2352 x 1568 pixels:
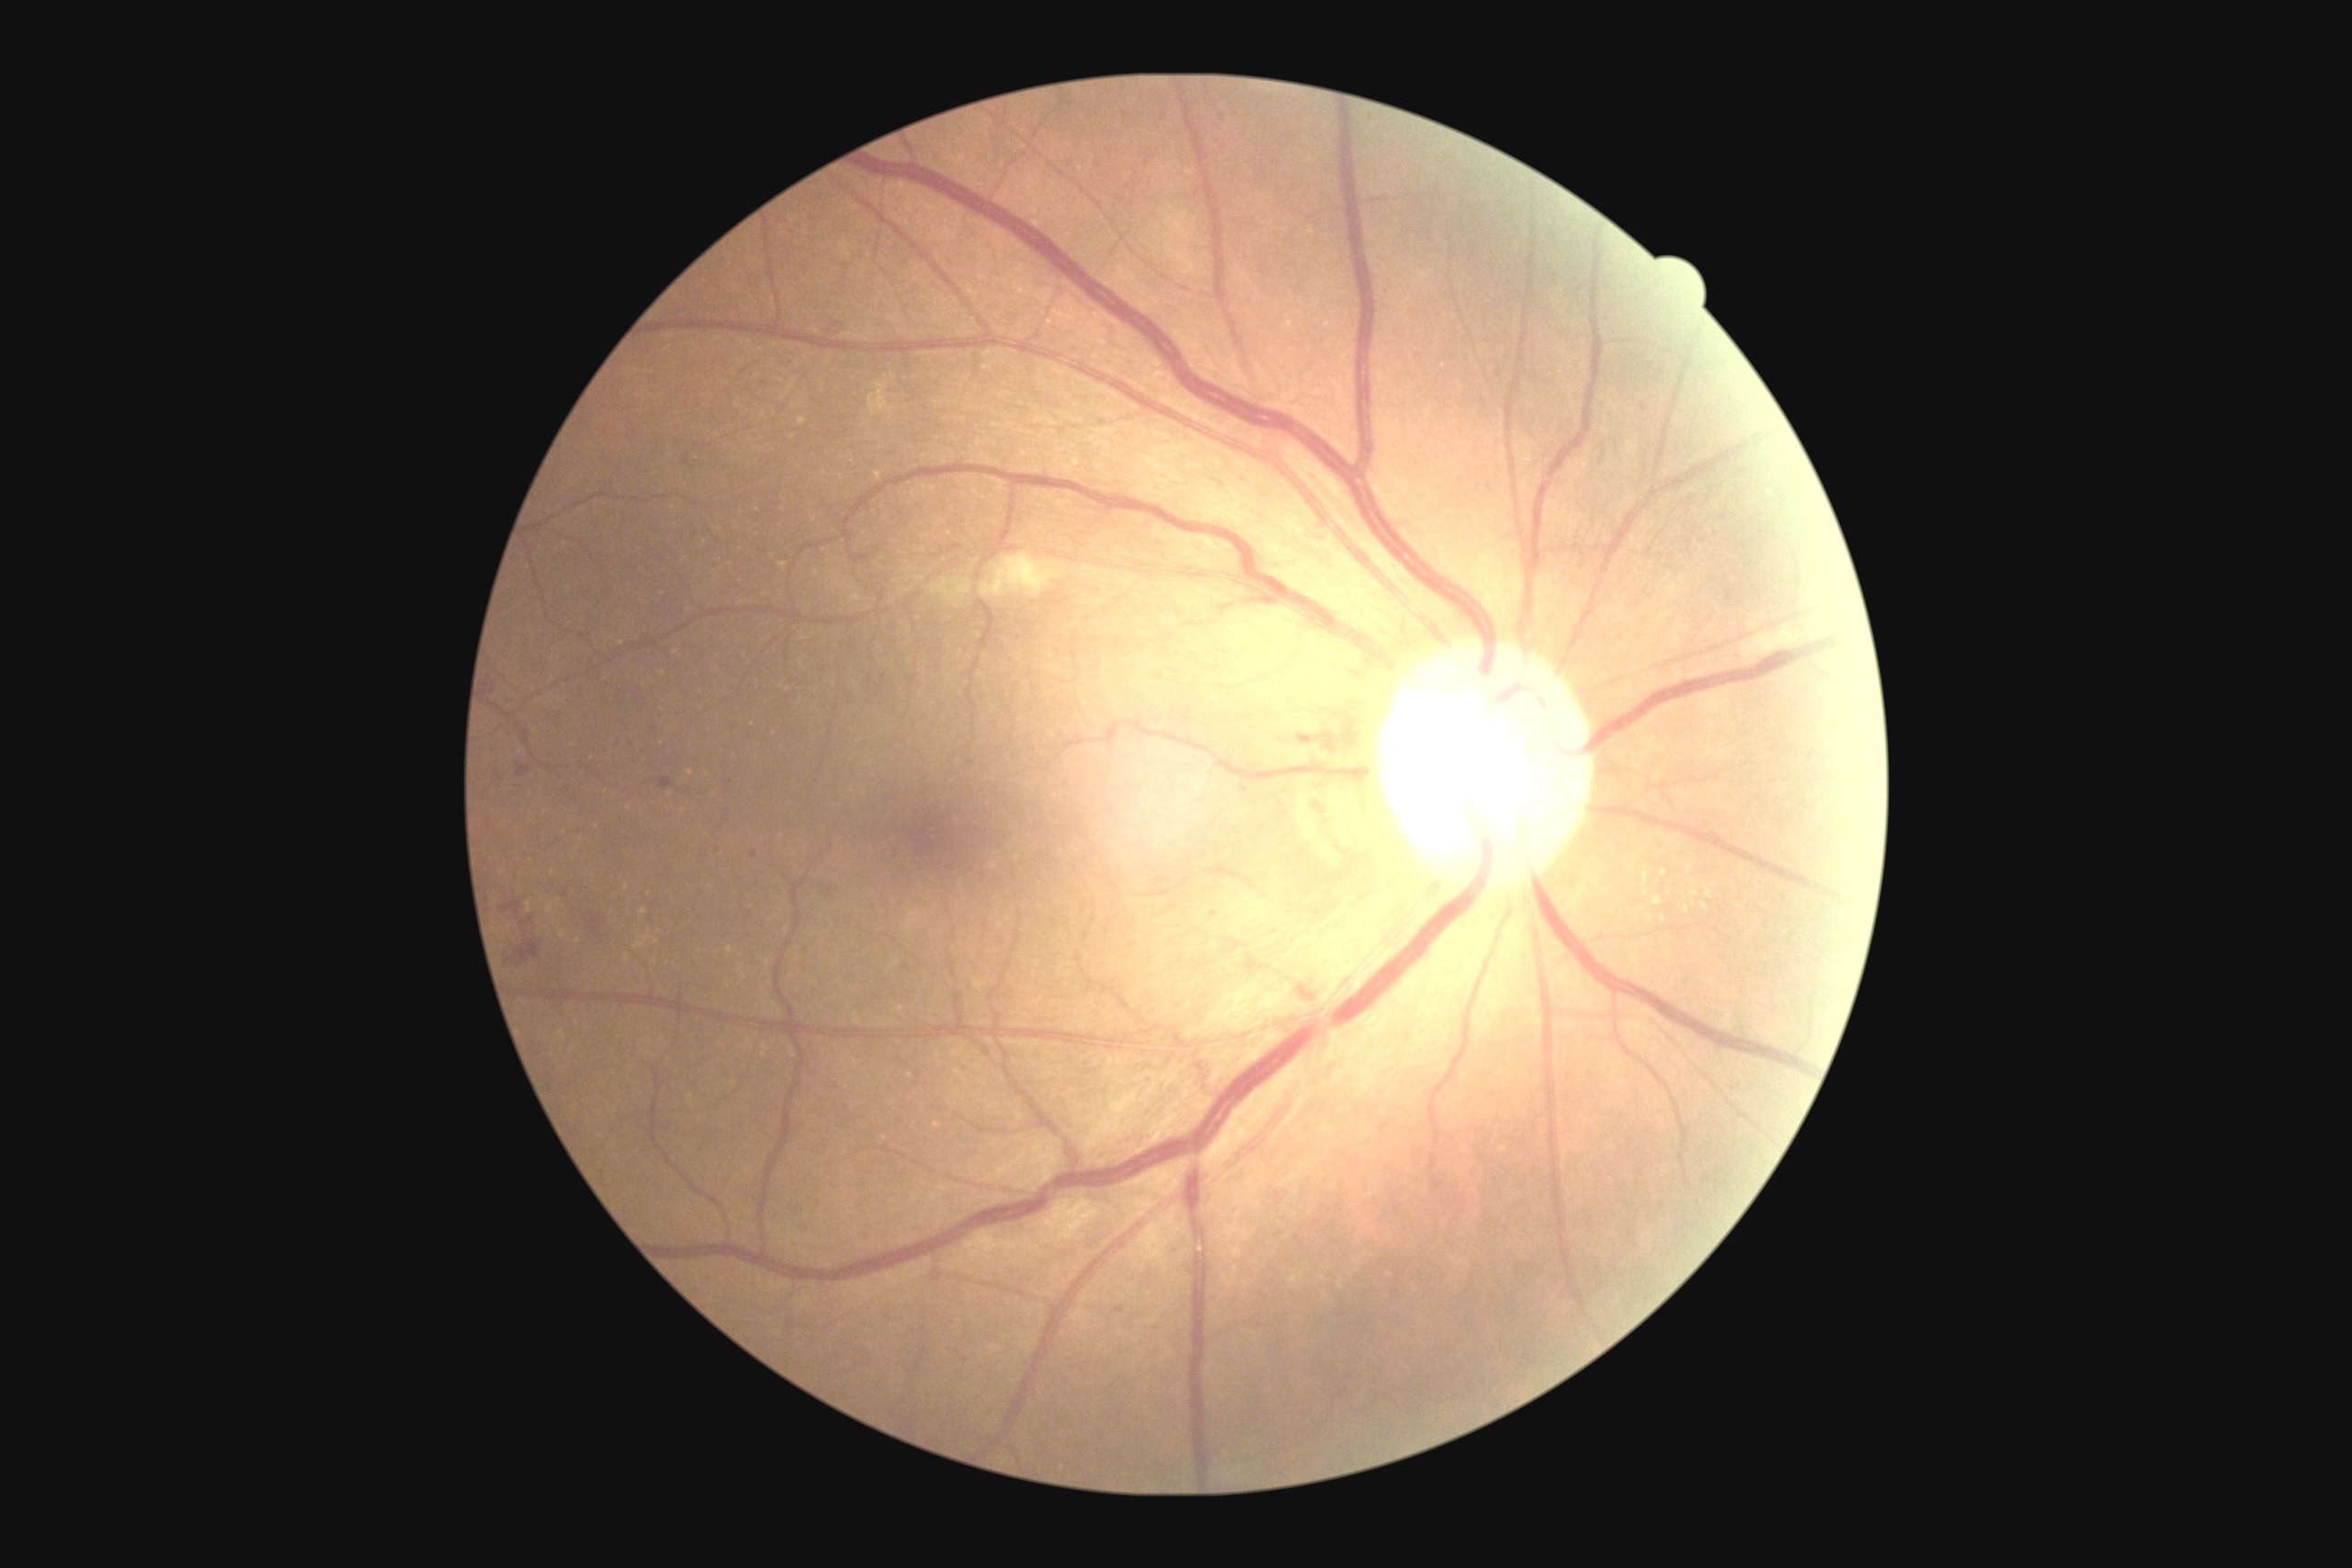 <lesions partial="true">
  <dr_grade>2</dr_grade>
  <se>{"x1": 930, "y1": 578, "x2": 974, "y2": 605}; {"x1": 981, "y1": 553, "x2": 1066, "y2": 598}; {"x1": 1741, "y1": 627, "x2": 1803, "y2": 660}</se>
  <ma partial="true">{"x1": 660, "y1": 778, "x2": 672, "y2": 790}; {"x1": 897, "y1": 1119, "x2": 905, "y2": 1124}; {"x1": 750, "y1": 850, "x2": 758, "y2": 859}; {"x1": 858, "y1": 251, "x2": 868, "y2": 260}; {"x1": 950, "y1": 544, "x2": 961, "y2": 551}; {"x1": 968, "y1": 760, "x2": 977, "y2": 767}; {"x1": 1295, "y1": 734, "x2": 1309, "y2": 747}; {"x1": 1736, "y1": 654, "x2": 1741, "y2": 662}; {"x1": 852, "y1": 554, "x2": 870, "y2": 565}; {"x1": 825, "y1": 320, "x2": 847, "y2": 340}; {"x1": 1311, "y1": 801, "x2": 1324, "y2": 812}</ma>
  <ma_small_centers>[904, 264]; [1214, 914]; [729, 782]</ma_small_centers>
  <he>{"x1": 516, "y1": 939, "x2": 540, "y2": 966}; {"x1": 589, "y1": 916, "x2": 605, "y2": 937}</he>
  <ex partial="true">{"x1": 1685, "y1": 906, "x2": 1690, "y2": 914}; {"x1": 1660, "y1": 868, "x2": 1667, "y2": 877}; {"x1": 1654, "y1": 896, "x2": 1661, "y2": 906}; {"x1": 1643, "y1": 874, "x2": 1649, "y2": 888}; {"x1": 1690, "y1": 890, "x2": 1700, "y2": 897}; {"x1": 1710, "y1": 883, "x2": 1718, "y2": 888}; {"x1": 1701, "y1": 903, "x2": 1709, "y2": 910}; {"x1": 1705, "y1": 887, "x2": 1712, "y2": 899}</ex>
  <ex_small_centers>[1690, 869]; [1650, 917]; [1670, 893]; [1664, 919]; [1642, 909]; [1646, 893]; [1693, 903]</ex_small_centers>
</lesions>